640x480 · wide-field fundus photograph from neonatal ROP screening:
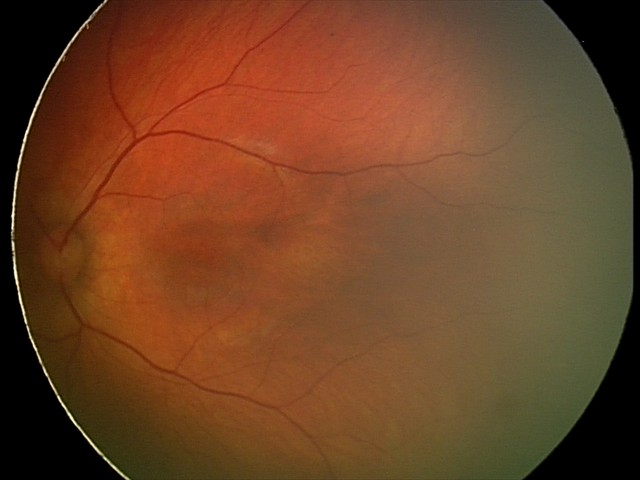
Impression: retinal hemorrhages.